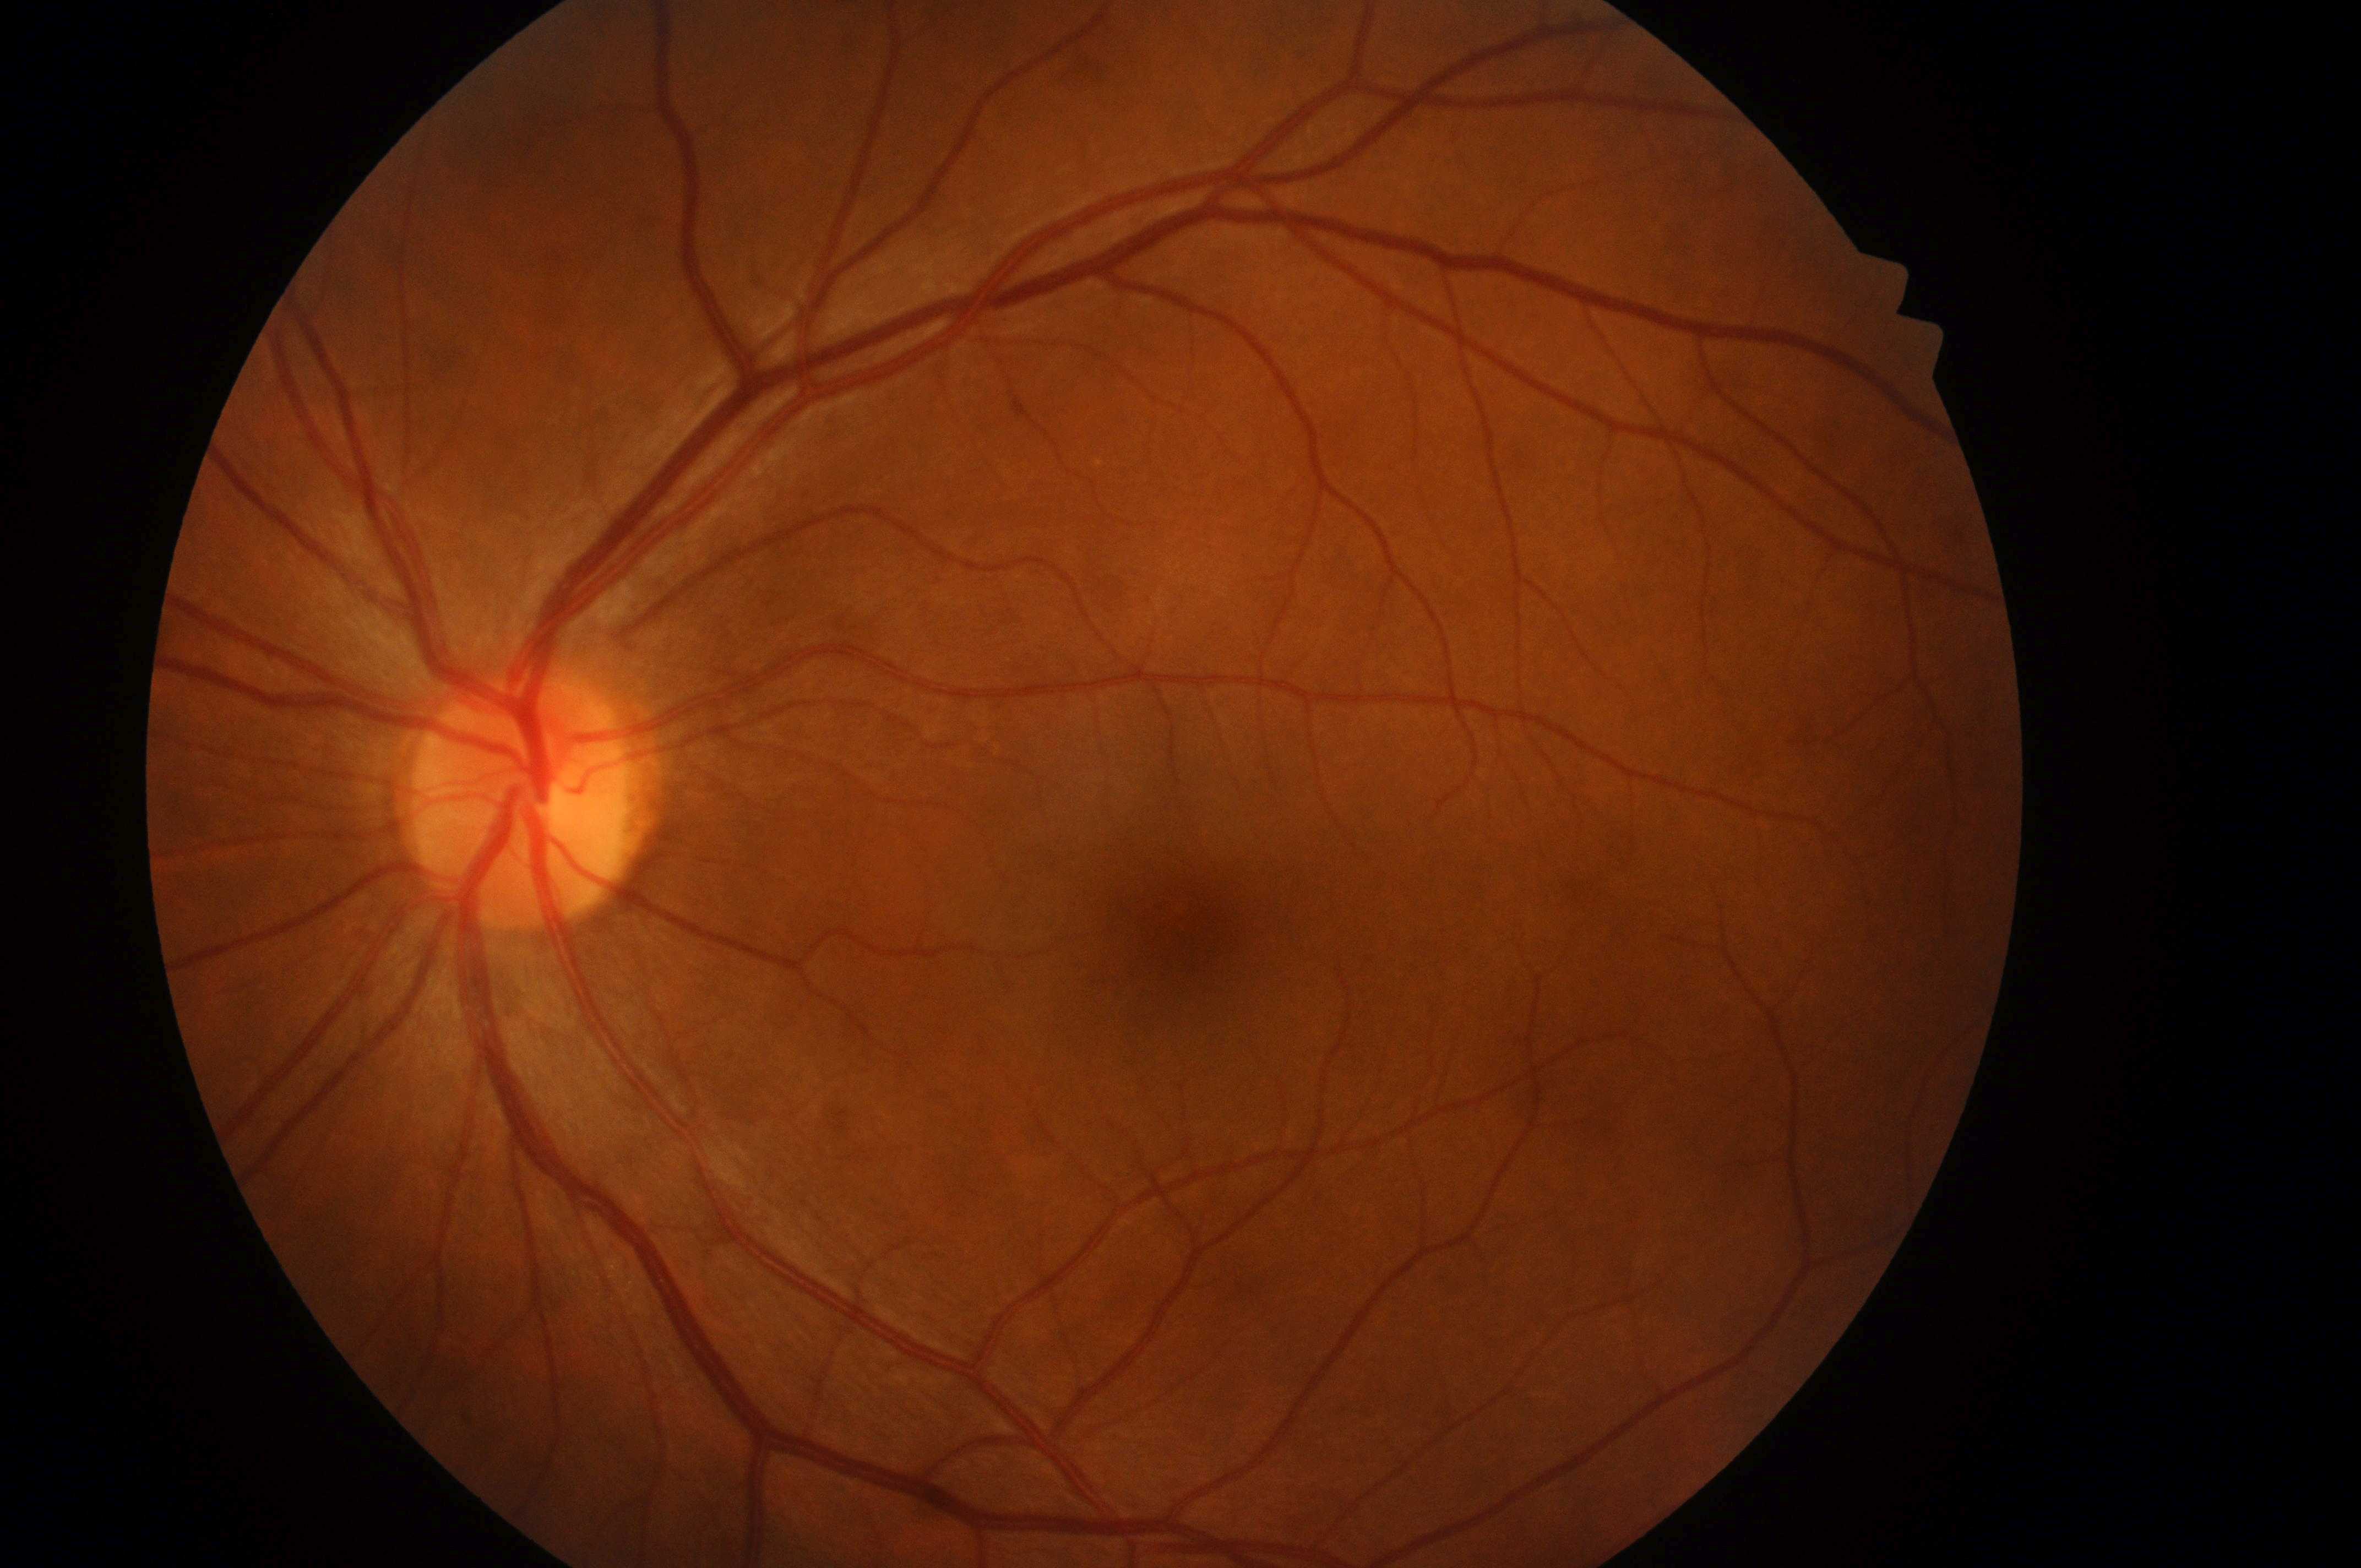
Q: Fovea center?
A: (1194,932)
Q: What is the laterality?
A: left
Q: What is the DR grade?
A: 0
Q: Locate the optic disc.
A: (518,808)
Q: What is the DME risk grade?
A: 0/2
Q: Is there DR or DME?
A: No DR or DME findings